45° field of view: 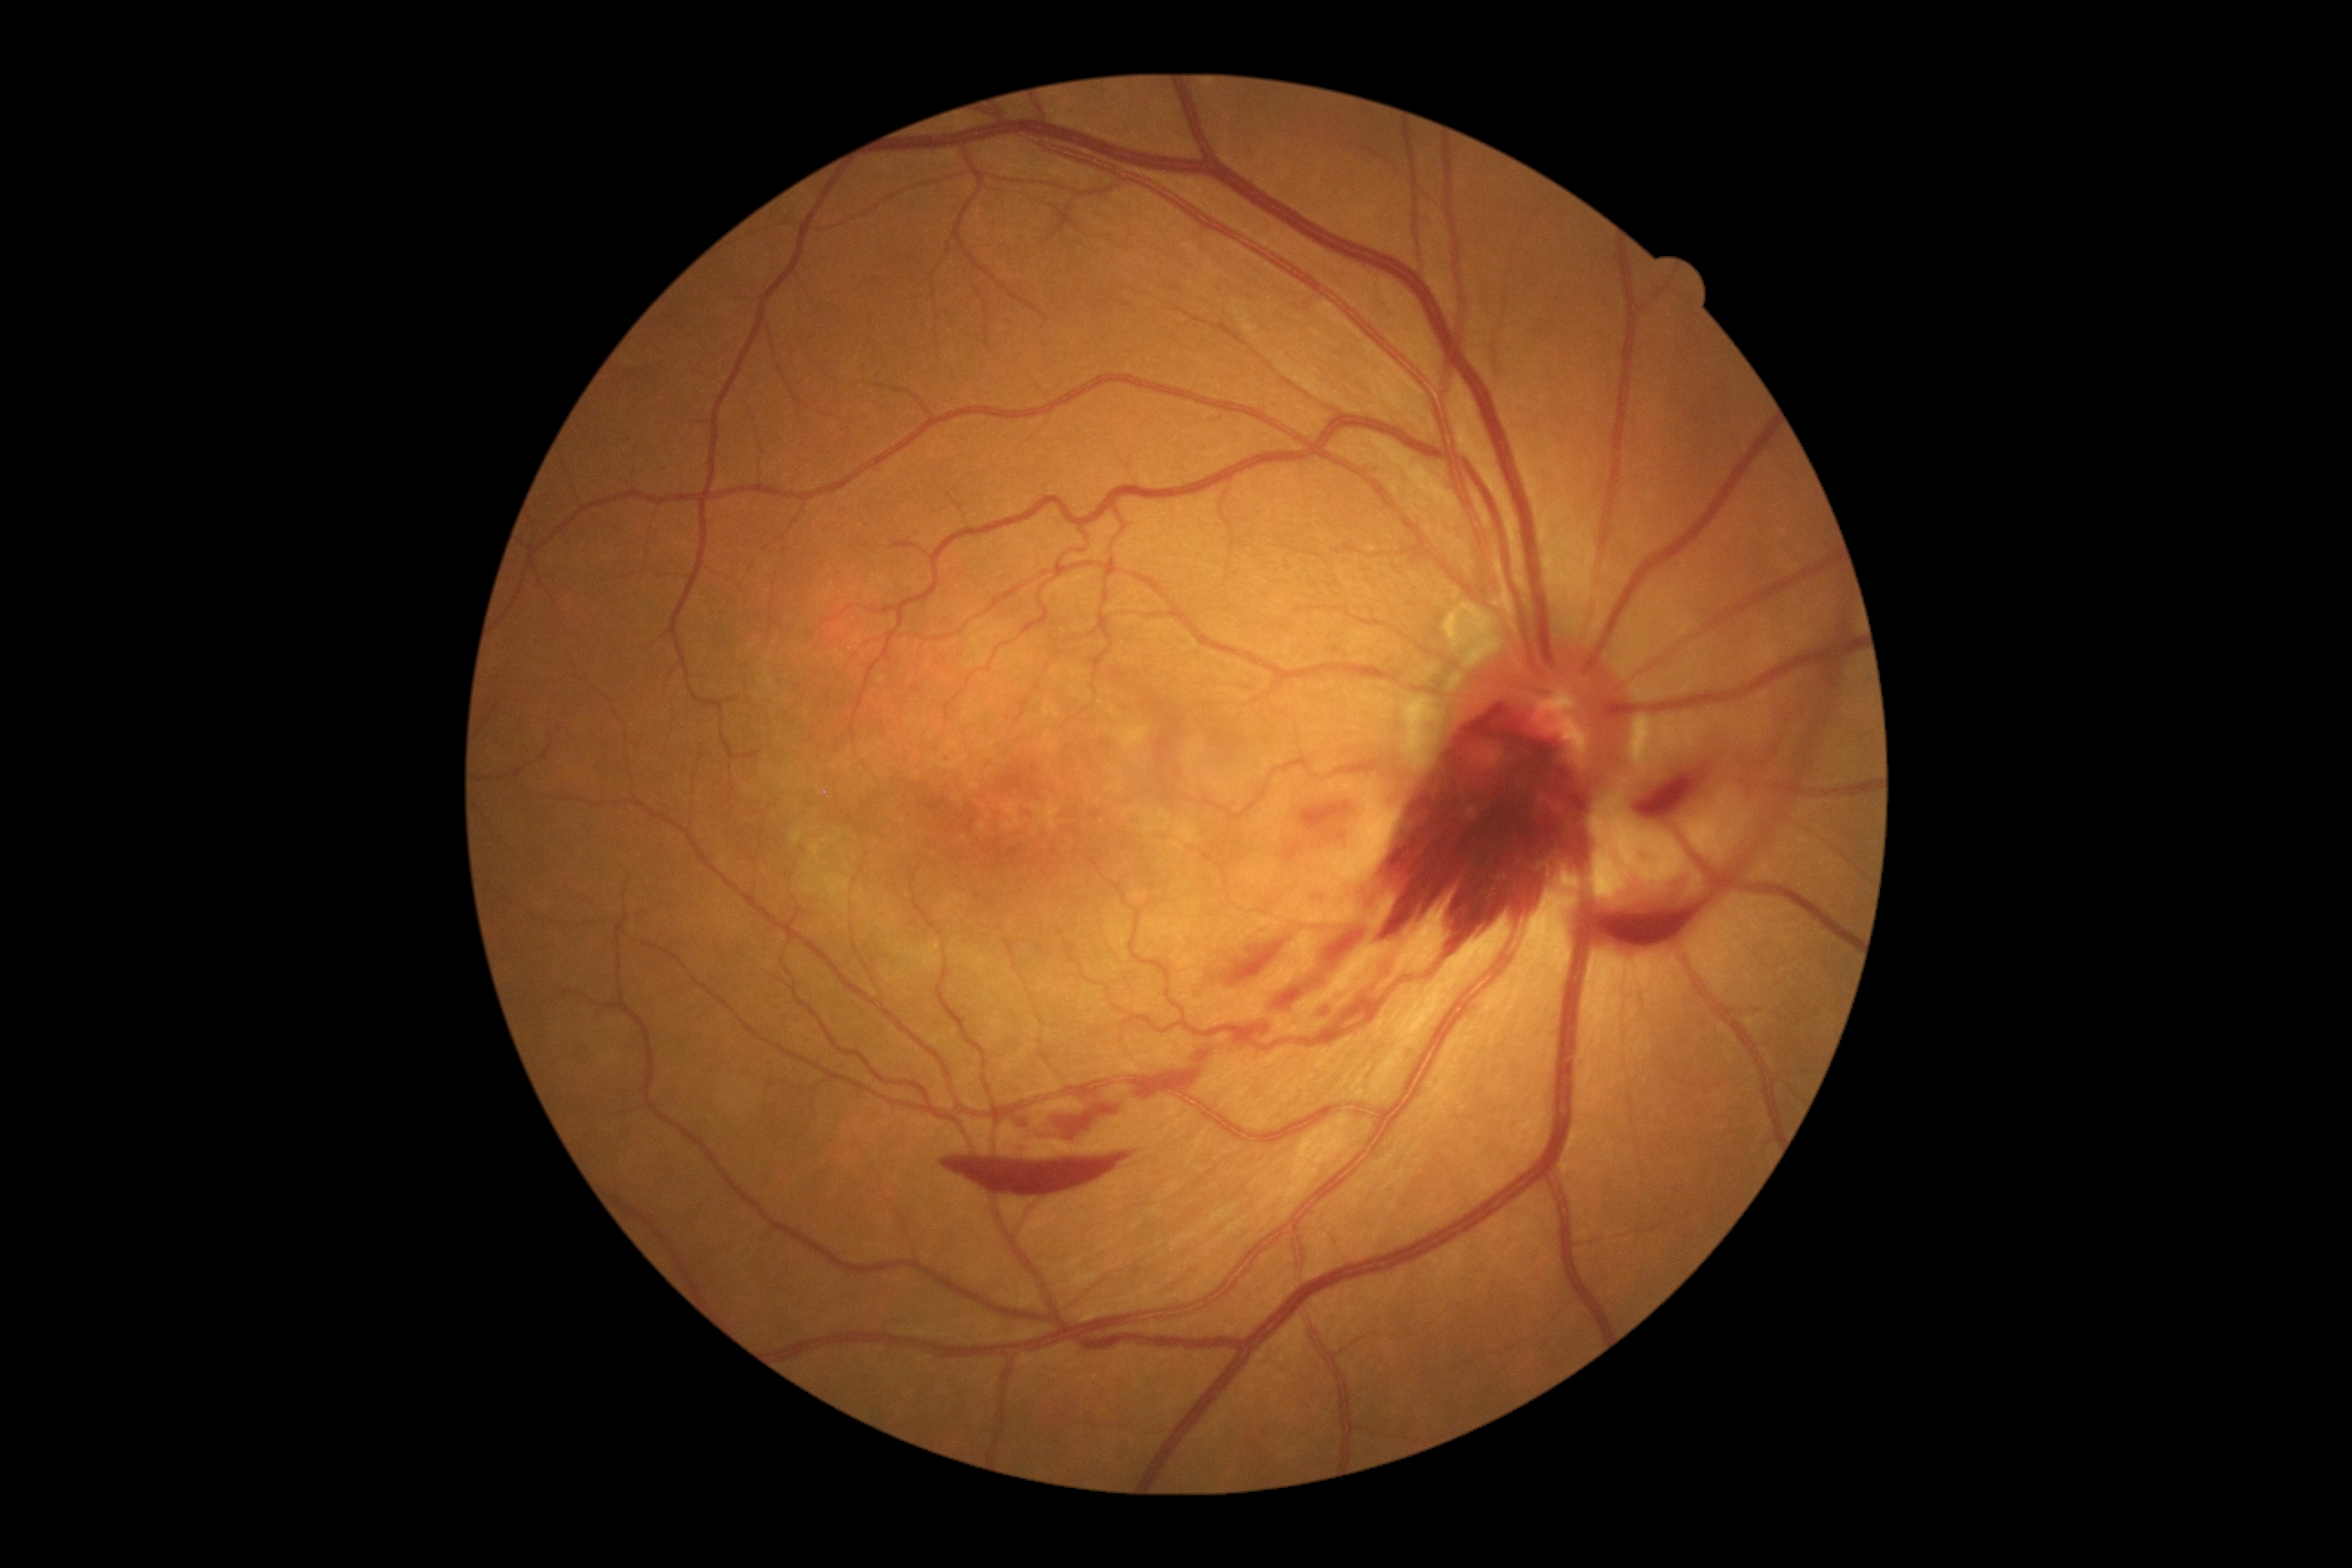 Retinopathy: grade 4 (PDR); proliferative diabetic retinopathy. Hemorrhages (partial list) at x1=1311 y1=890 x2=1333 y2=910 | x1=1188 y1=1044 x2=1220 y2=1066 | x1=1130 y1=1072 x2=1200 y2=1099 | x1=1199 y1=926 x2=1306 y2=992 | x1=1226 y1=1019 x2=1277 y2=1052 | x1=1266 y1=928 x2=1373 y2=1015 | x1=943 y1=1155 x2=1133 y2=1193 | x1=1280 y1=796 x2=1373 y2=863 | x1=1324 y1=952 x2=1400 y2=1043 | x1=1313 y1=994 x2=1348 y2=1023 | x1=1571 y1=683 x2=1841 y2=945 | x1=1845 y1=625 x2=1856 y2=667 | x1=1008 y1=1088 x2=1128 y2=1153 | x1=1338 y1=705 x2=1598 y2=950 | x1=1629 y1=734 x2=1734 y2=825. No hard exudates identified. No soft exudates identified. No microaneurysms identified.